Image size 1932x1932 · acquired with a Topcon TRC-NW8 — 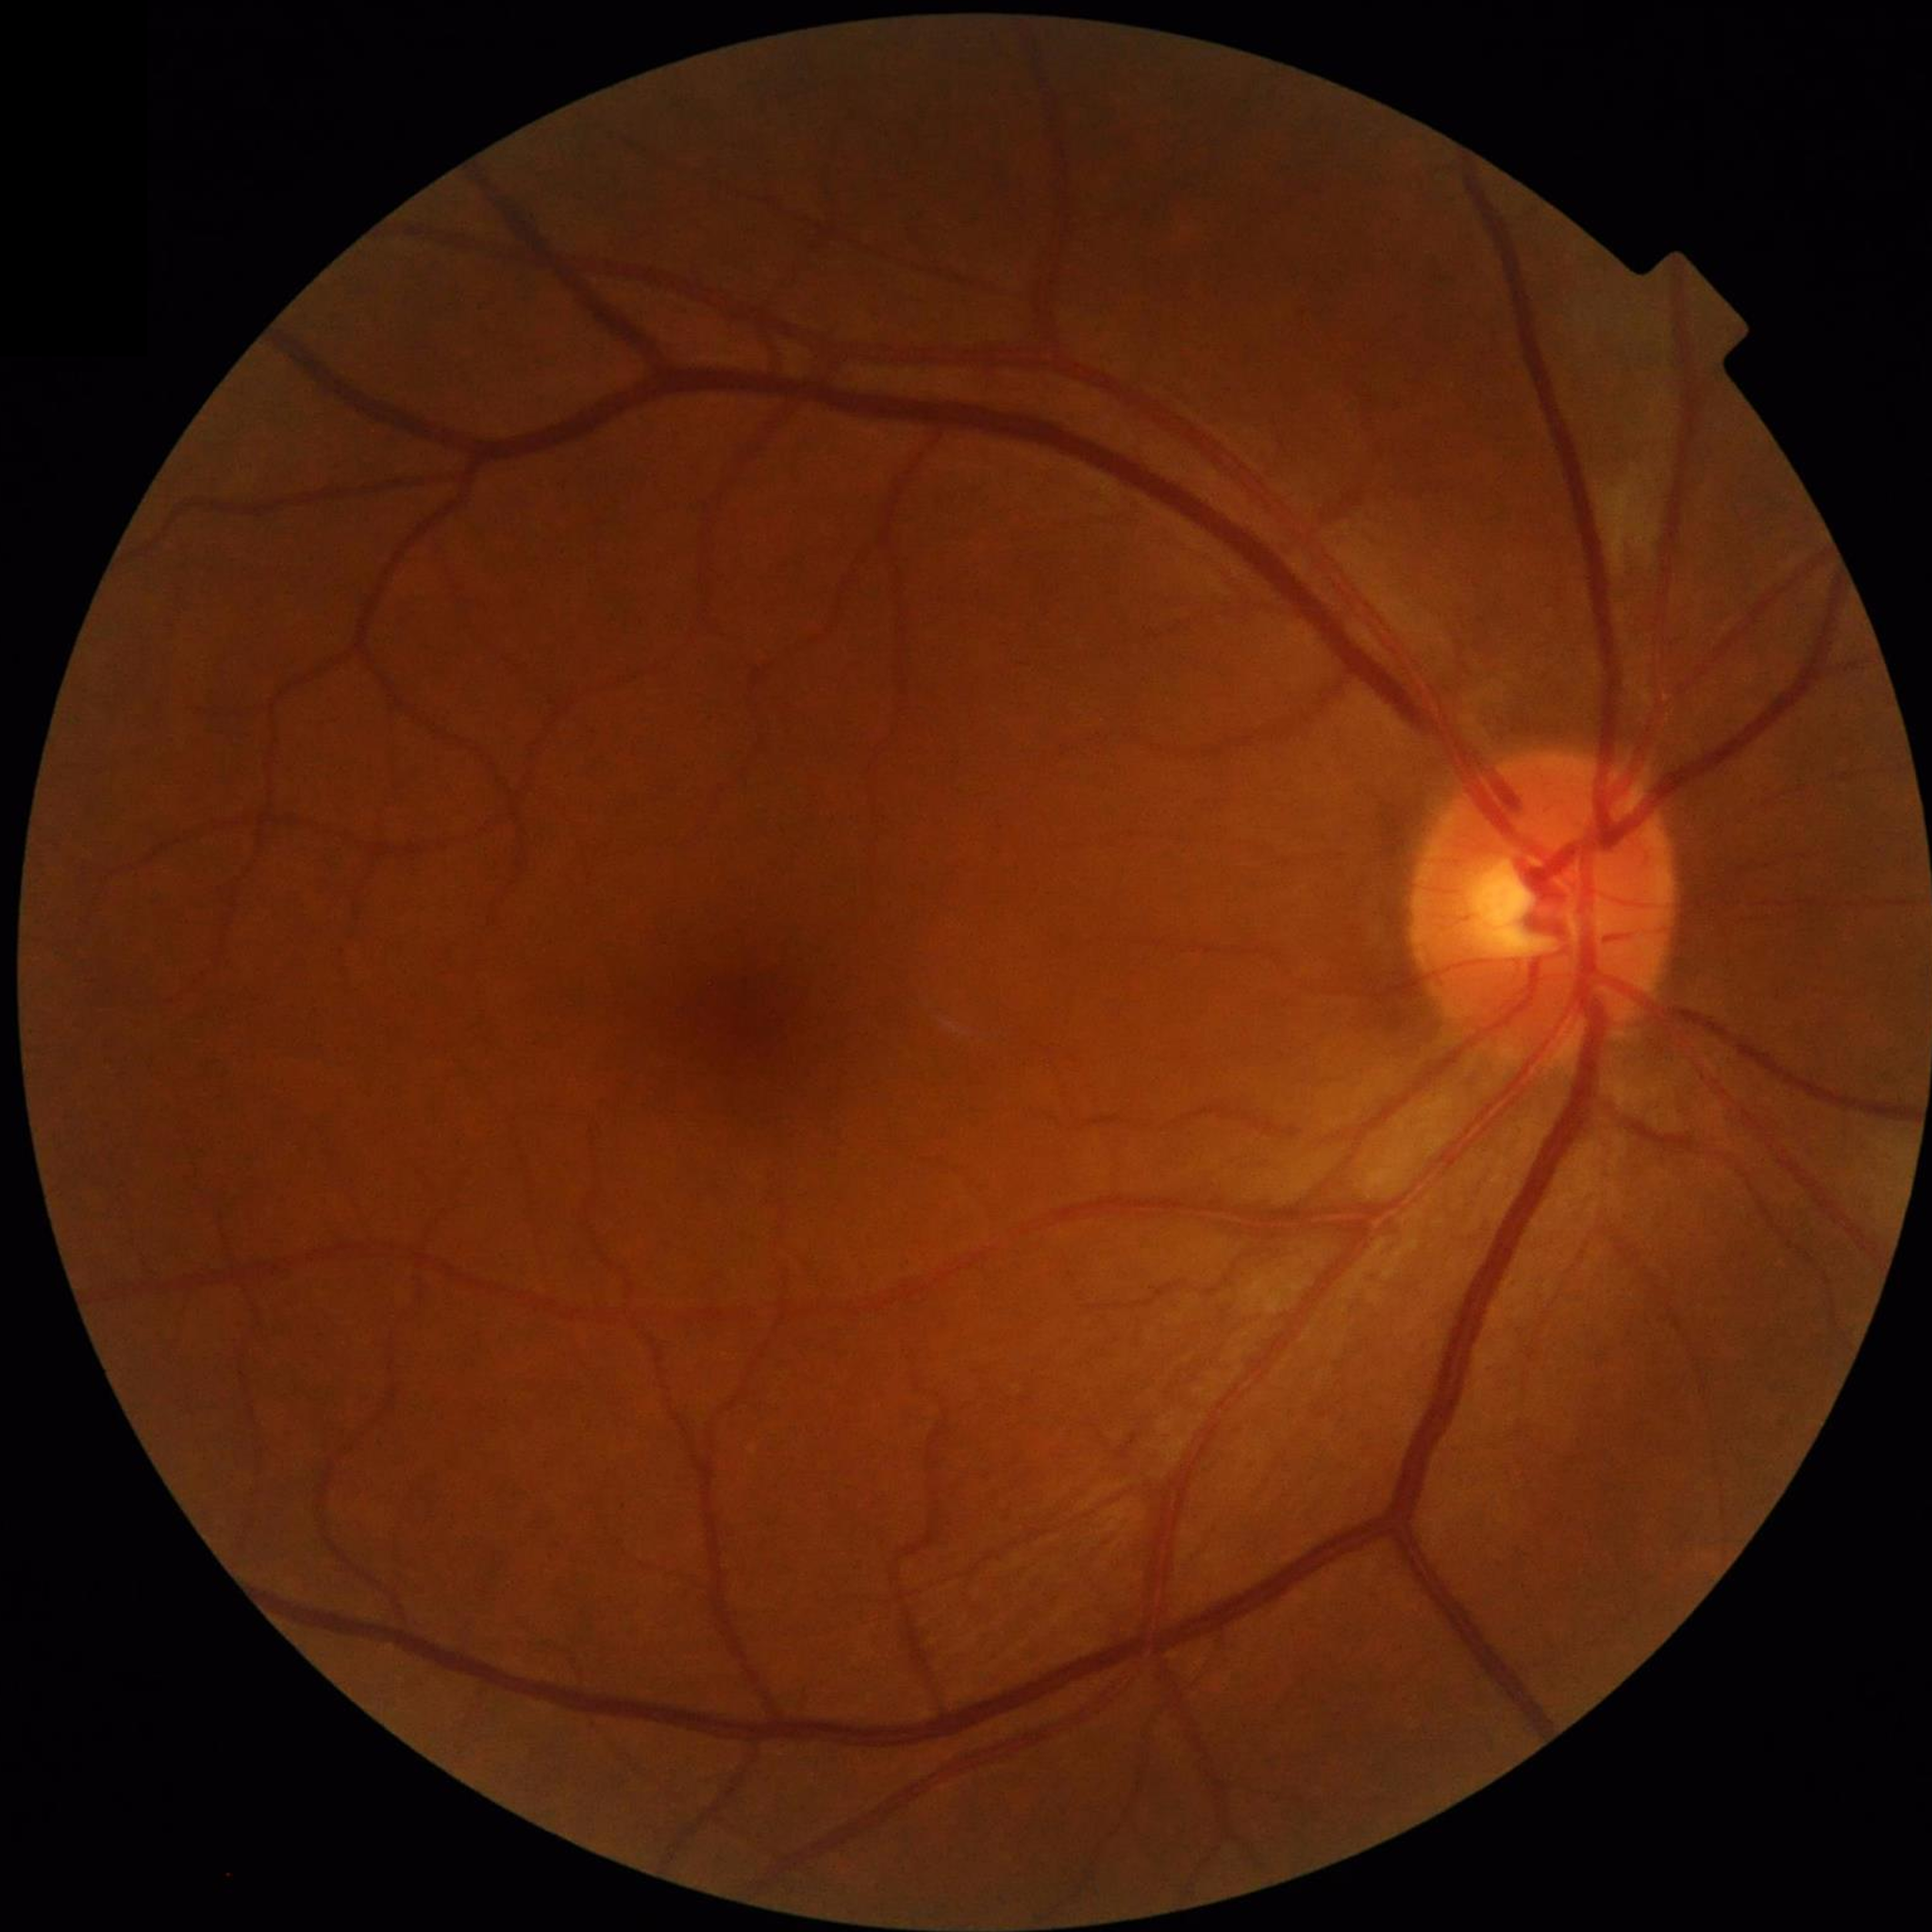
Quality: no concerns identified; Disease: no AMD, diabetic retinopathy, or glaucoma.